1240x1240. Captured with the Phoenix ICON (100° field of view). Wide-field fundus photograph of an infant: 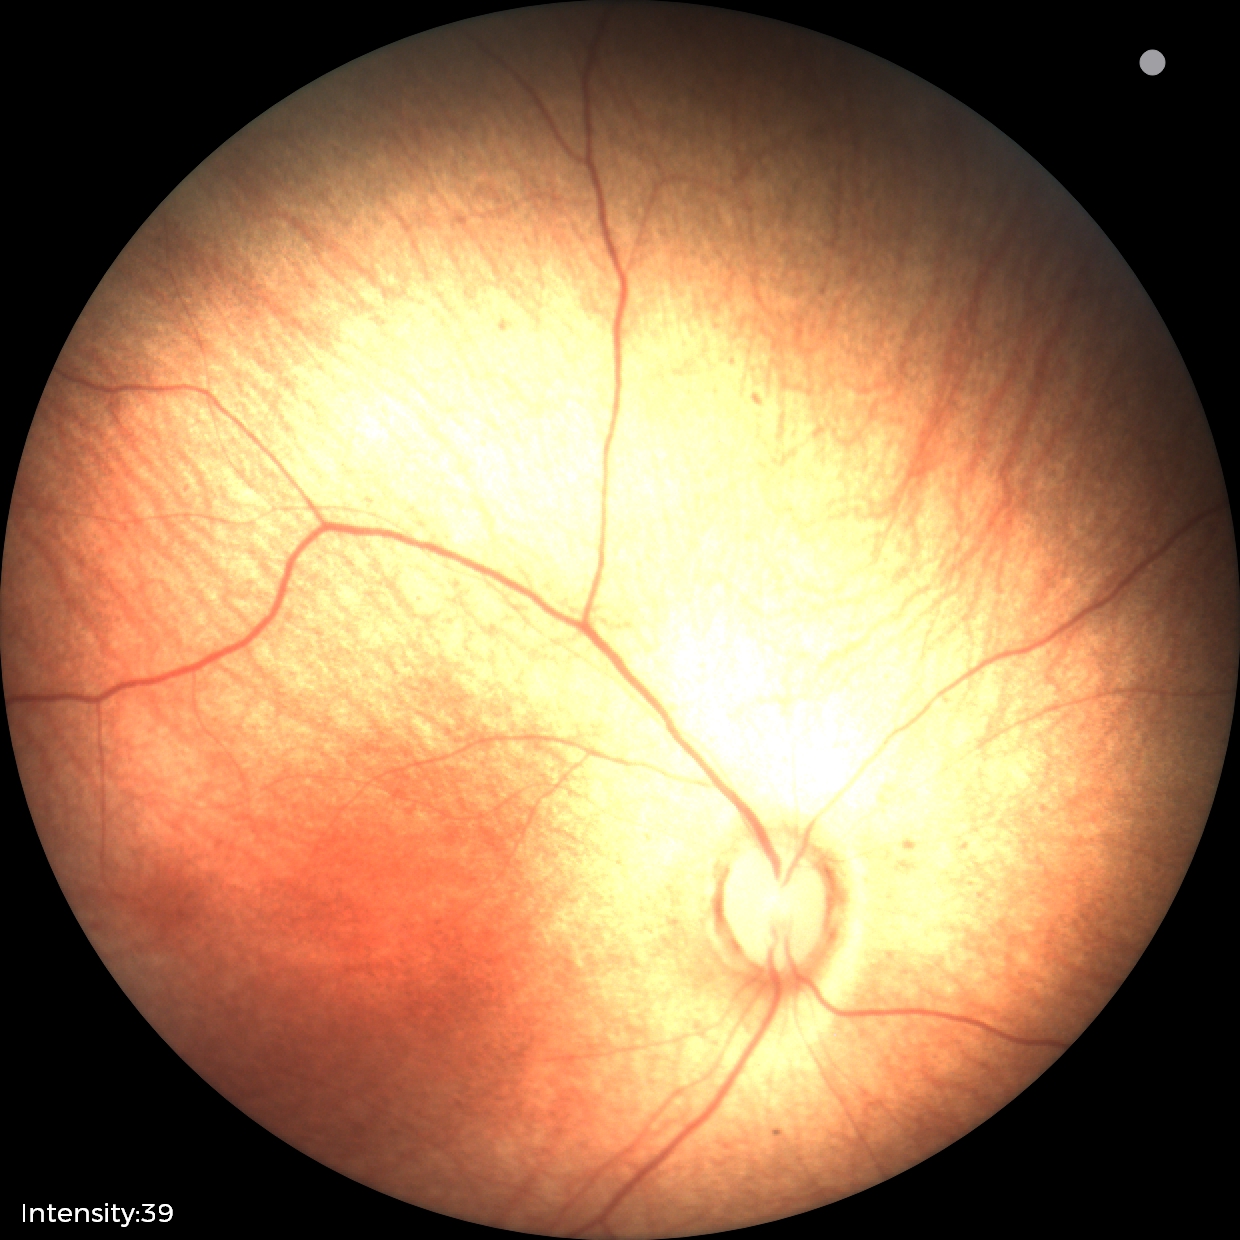
Screening examination diagnosed as physiological.